1380x1382px — 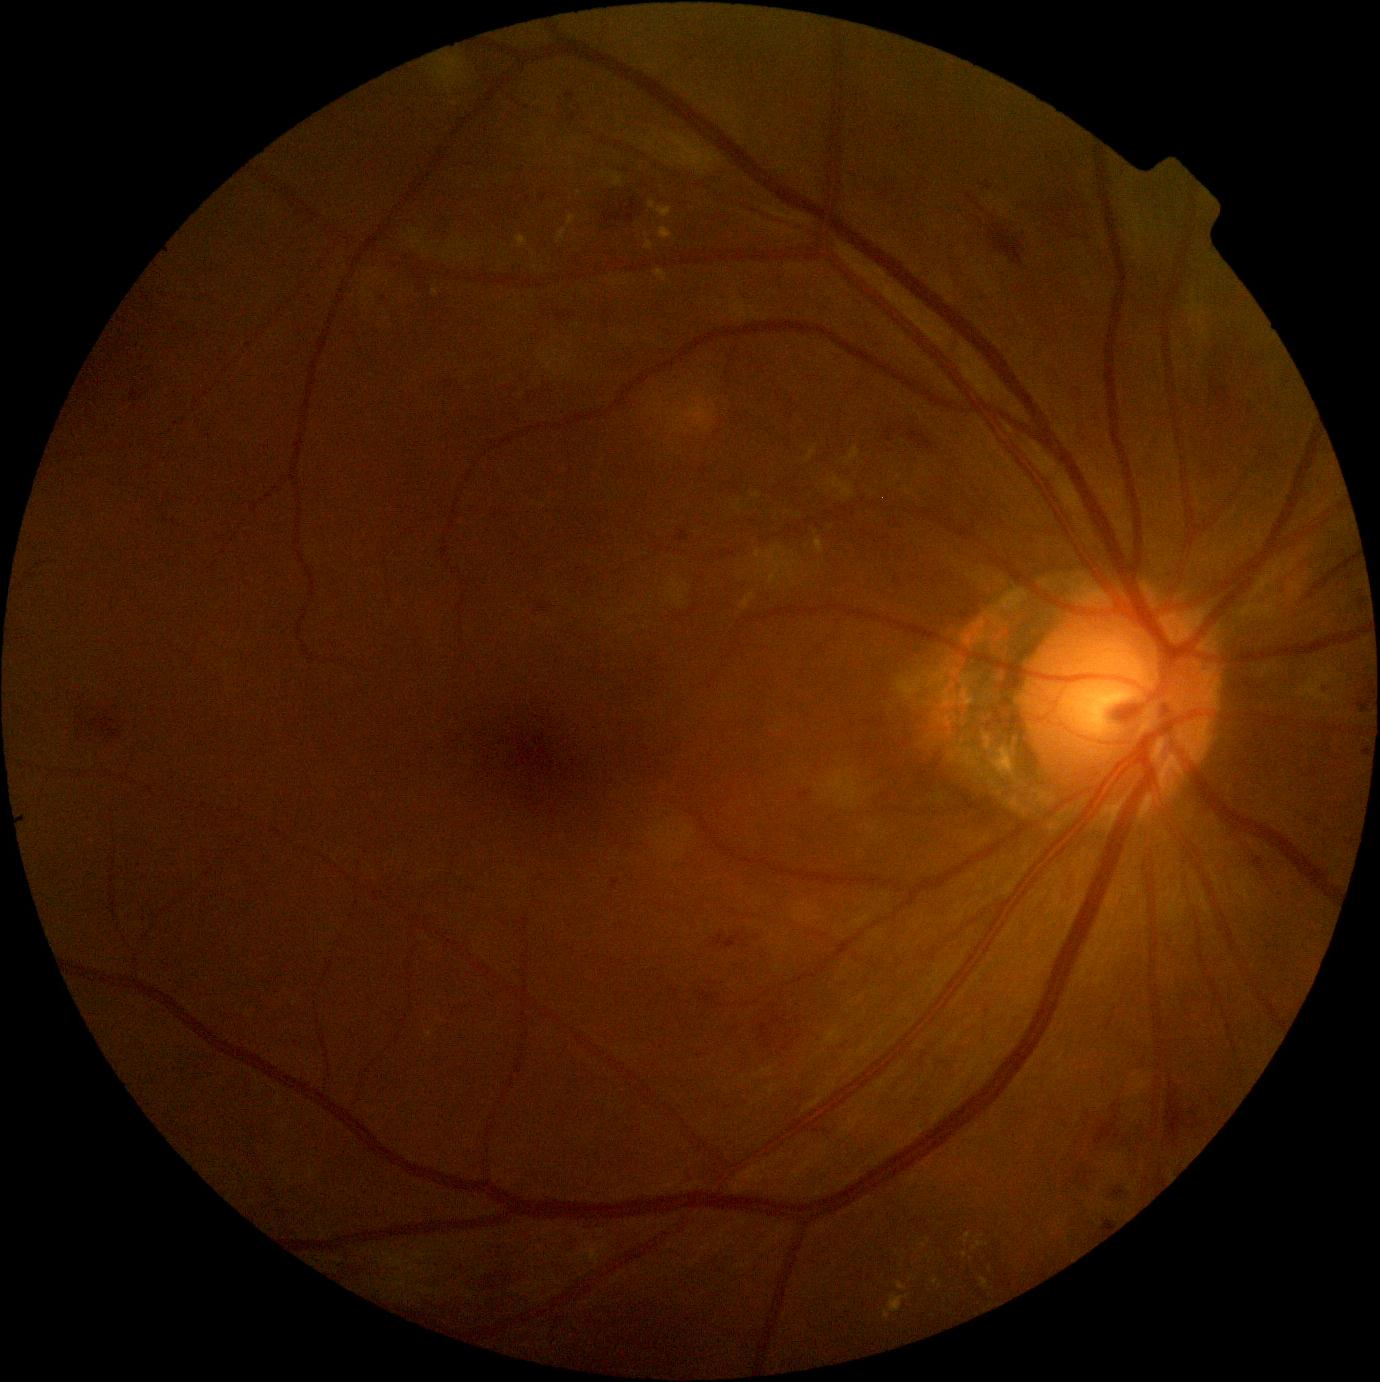

diabetic retinopathy grade = 2/4 — more than just microaneurysms but less than severe NPDR